Wide-field fundus photograph from neonatal ROP screening. 130° field of view (Natus RetCam Envision) — 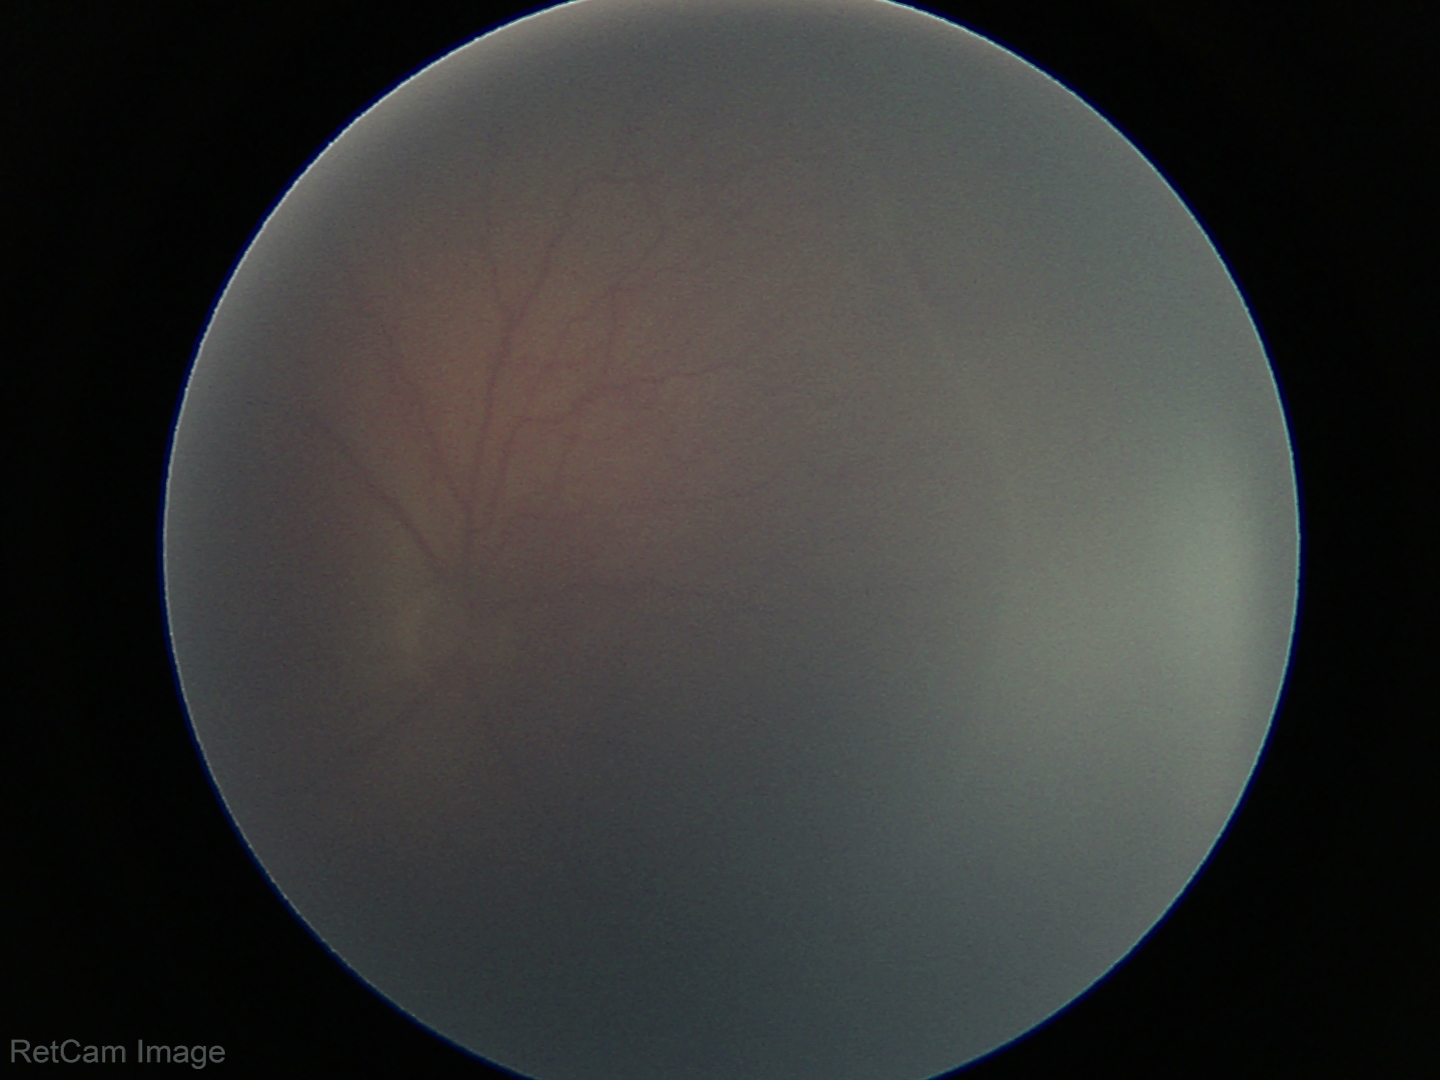

Series diagnosed as ROP stage 2.